Handheld portable fundus camera image: 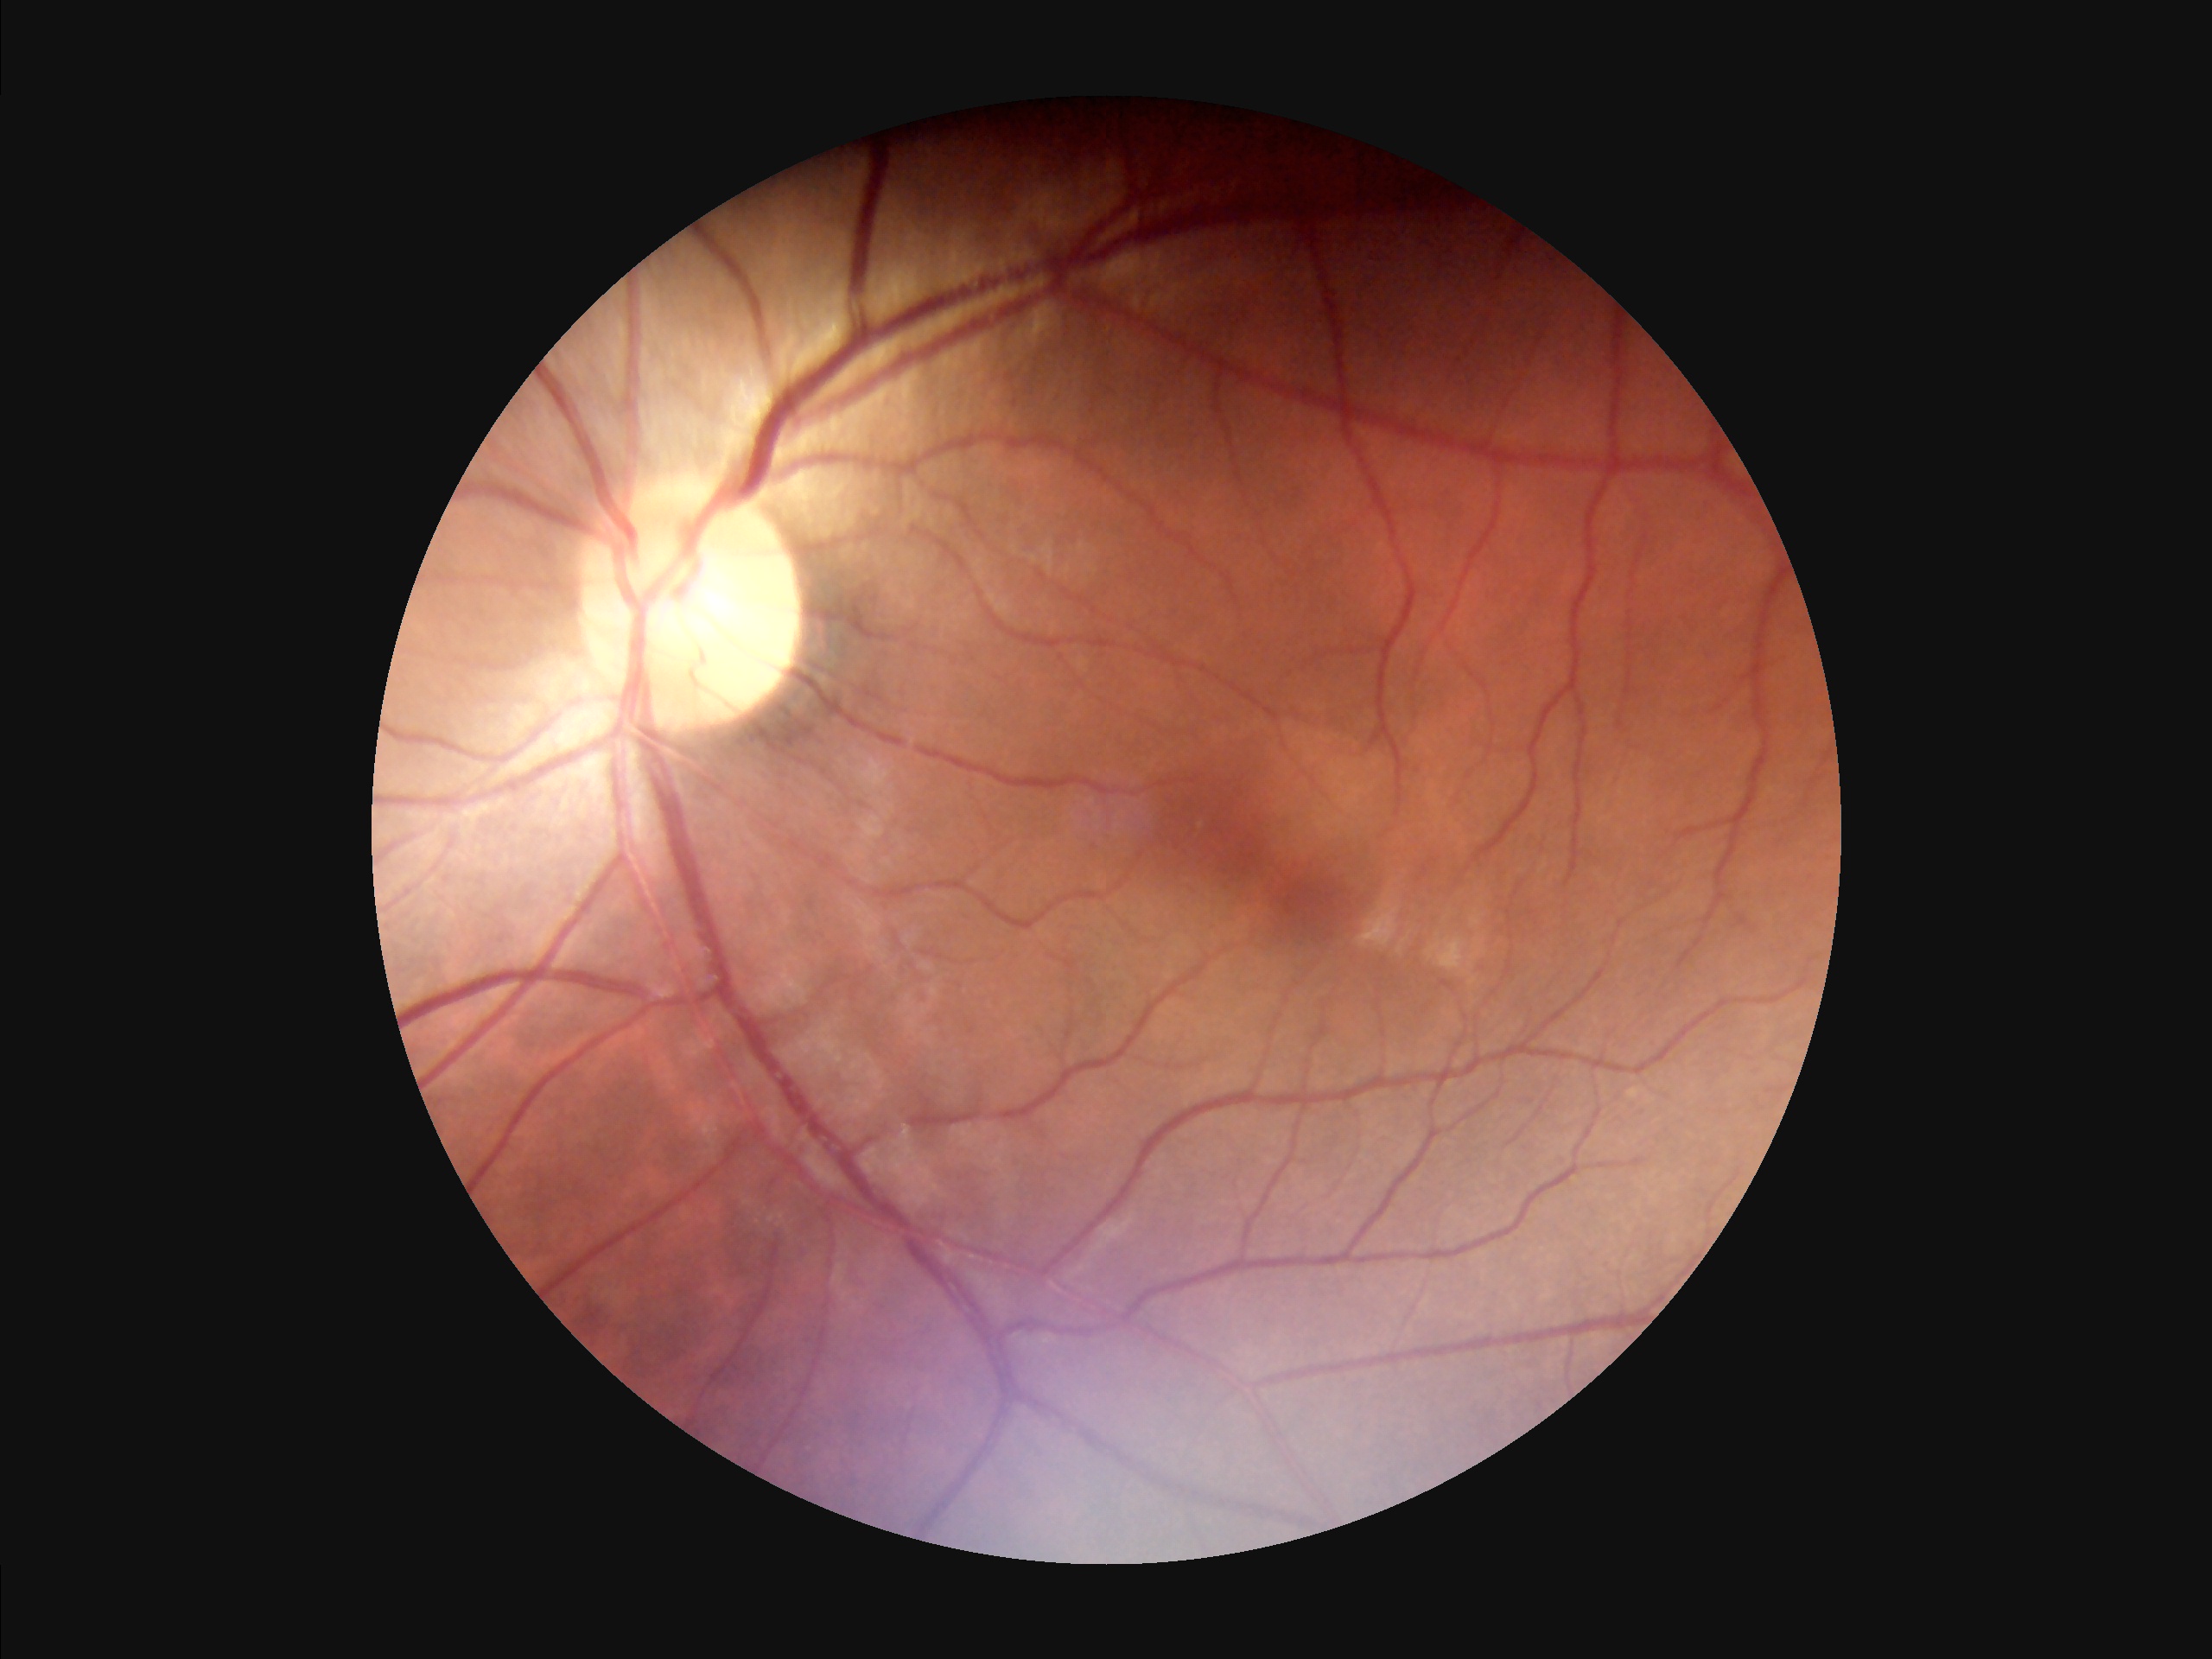
Contrast: satisfactory; Overall quality: adequate.